Portable fundus camera image.
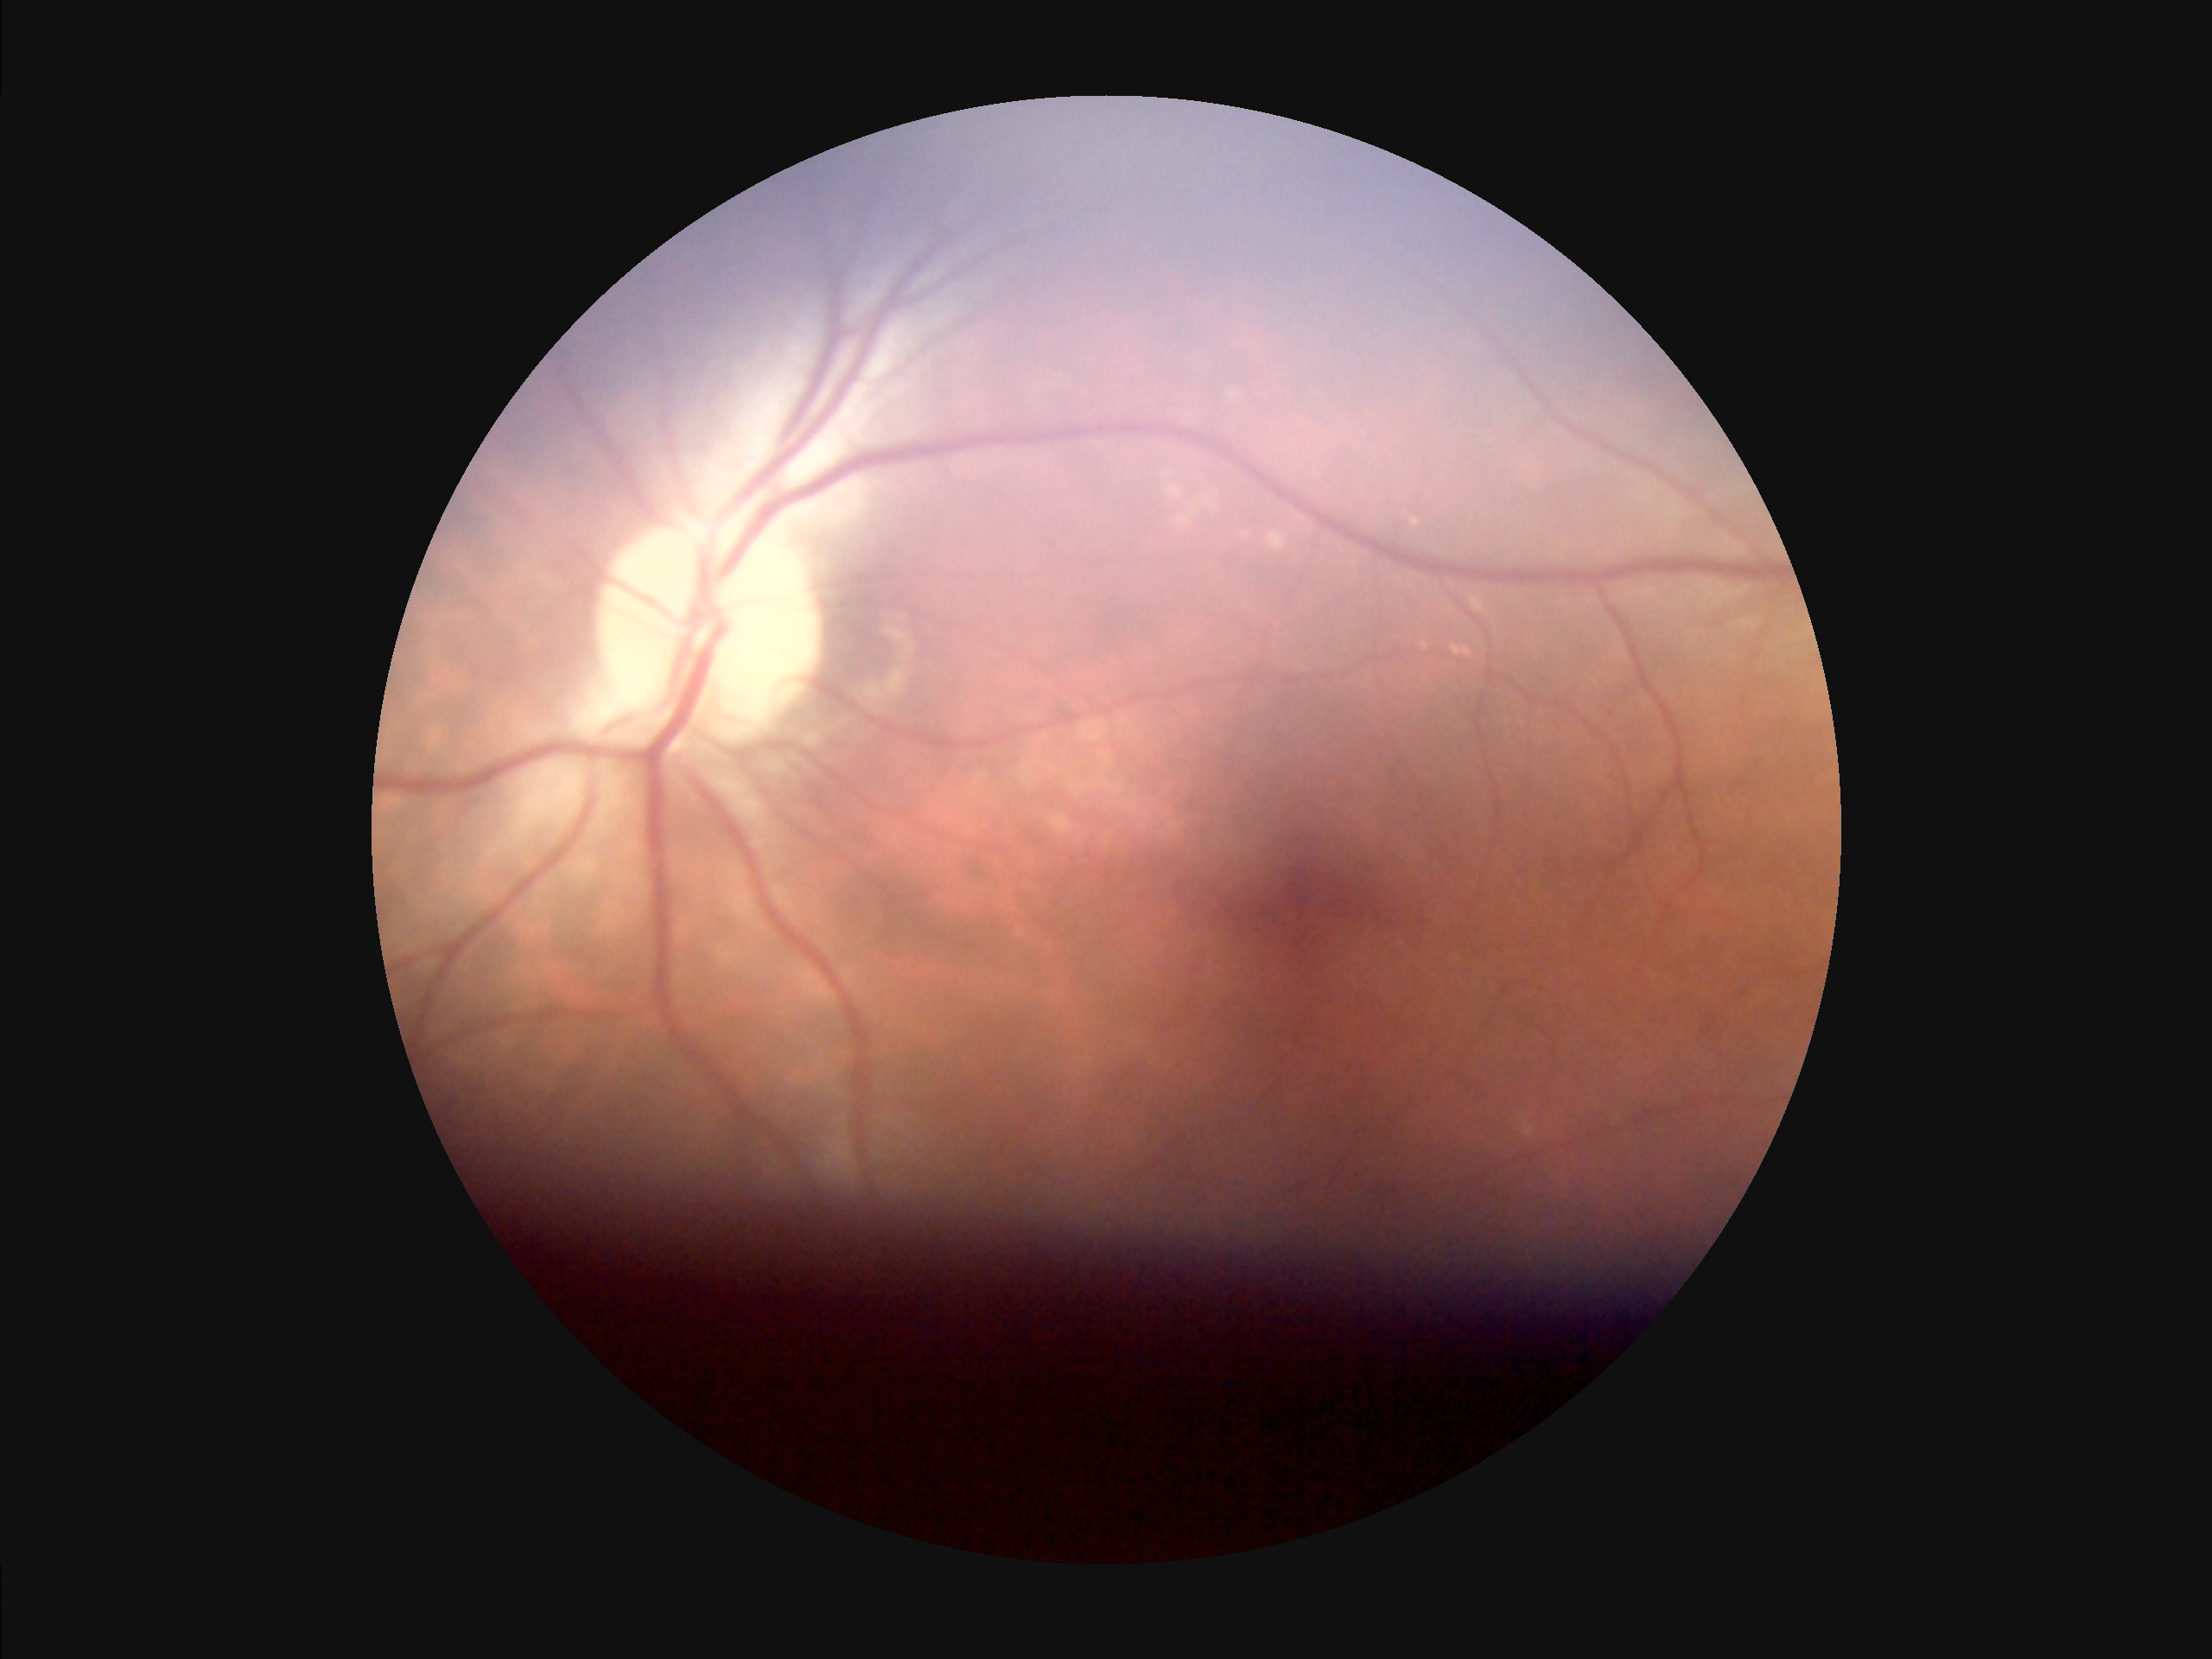
clarity: sharp
contrast: good
overall_quality: inadequate
illumination: uneven